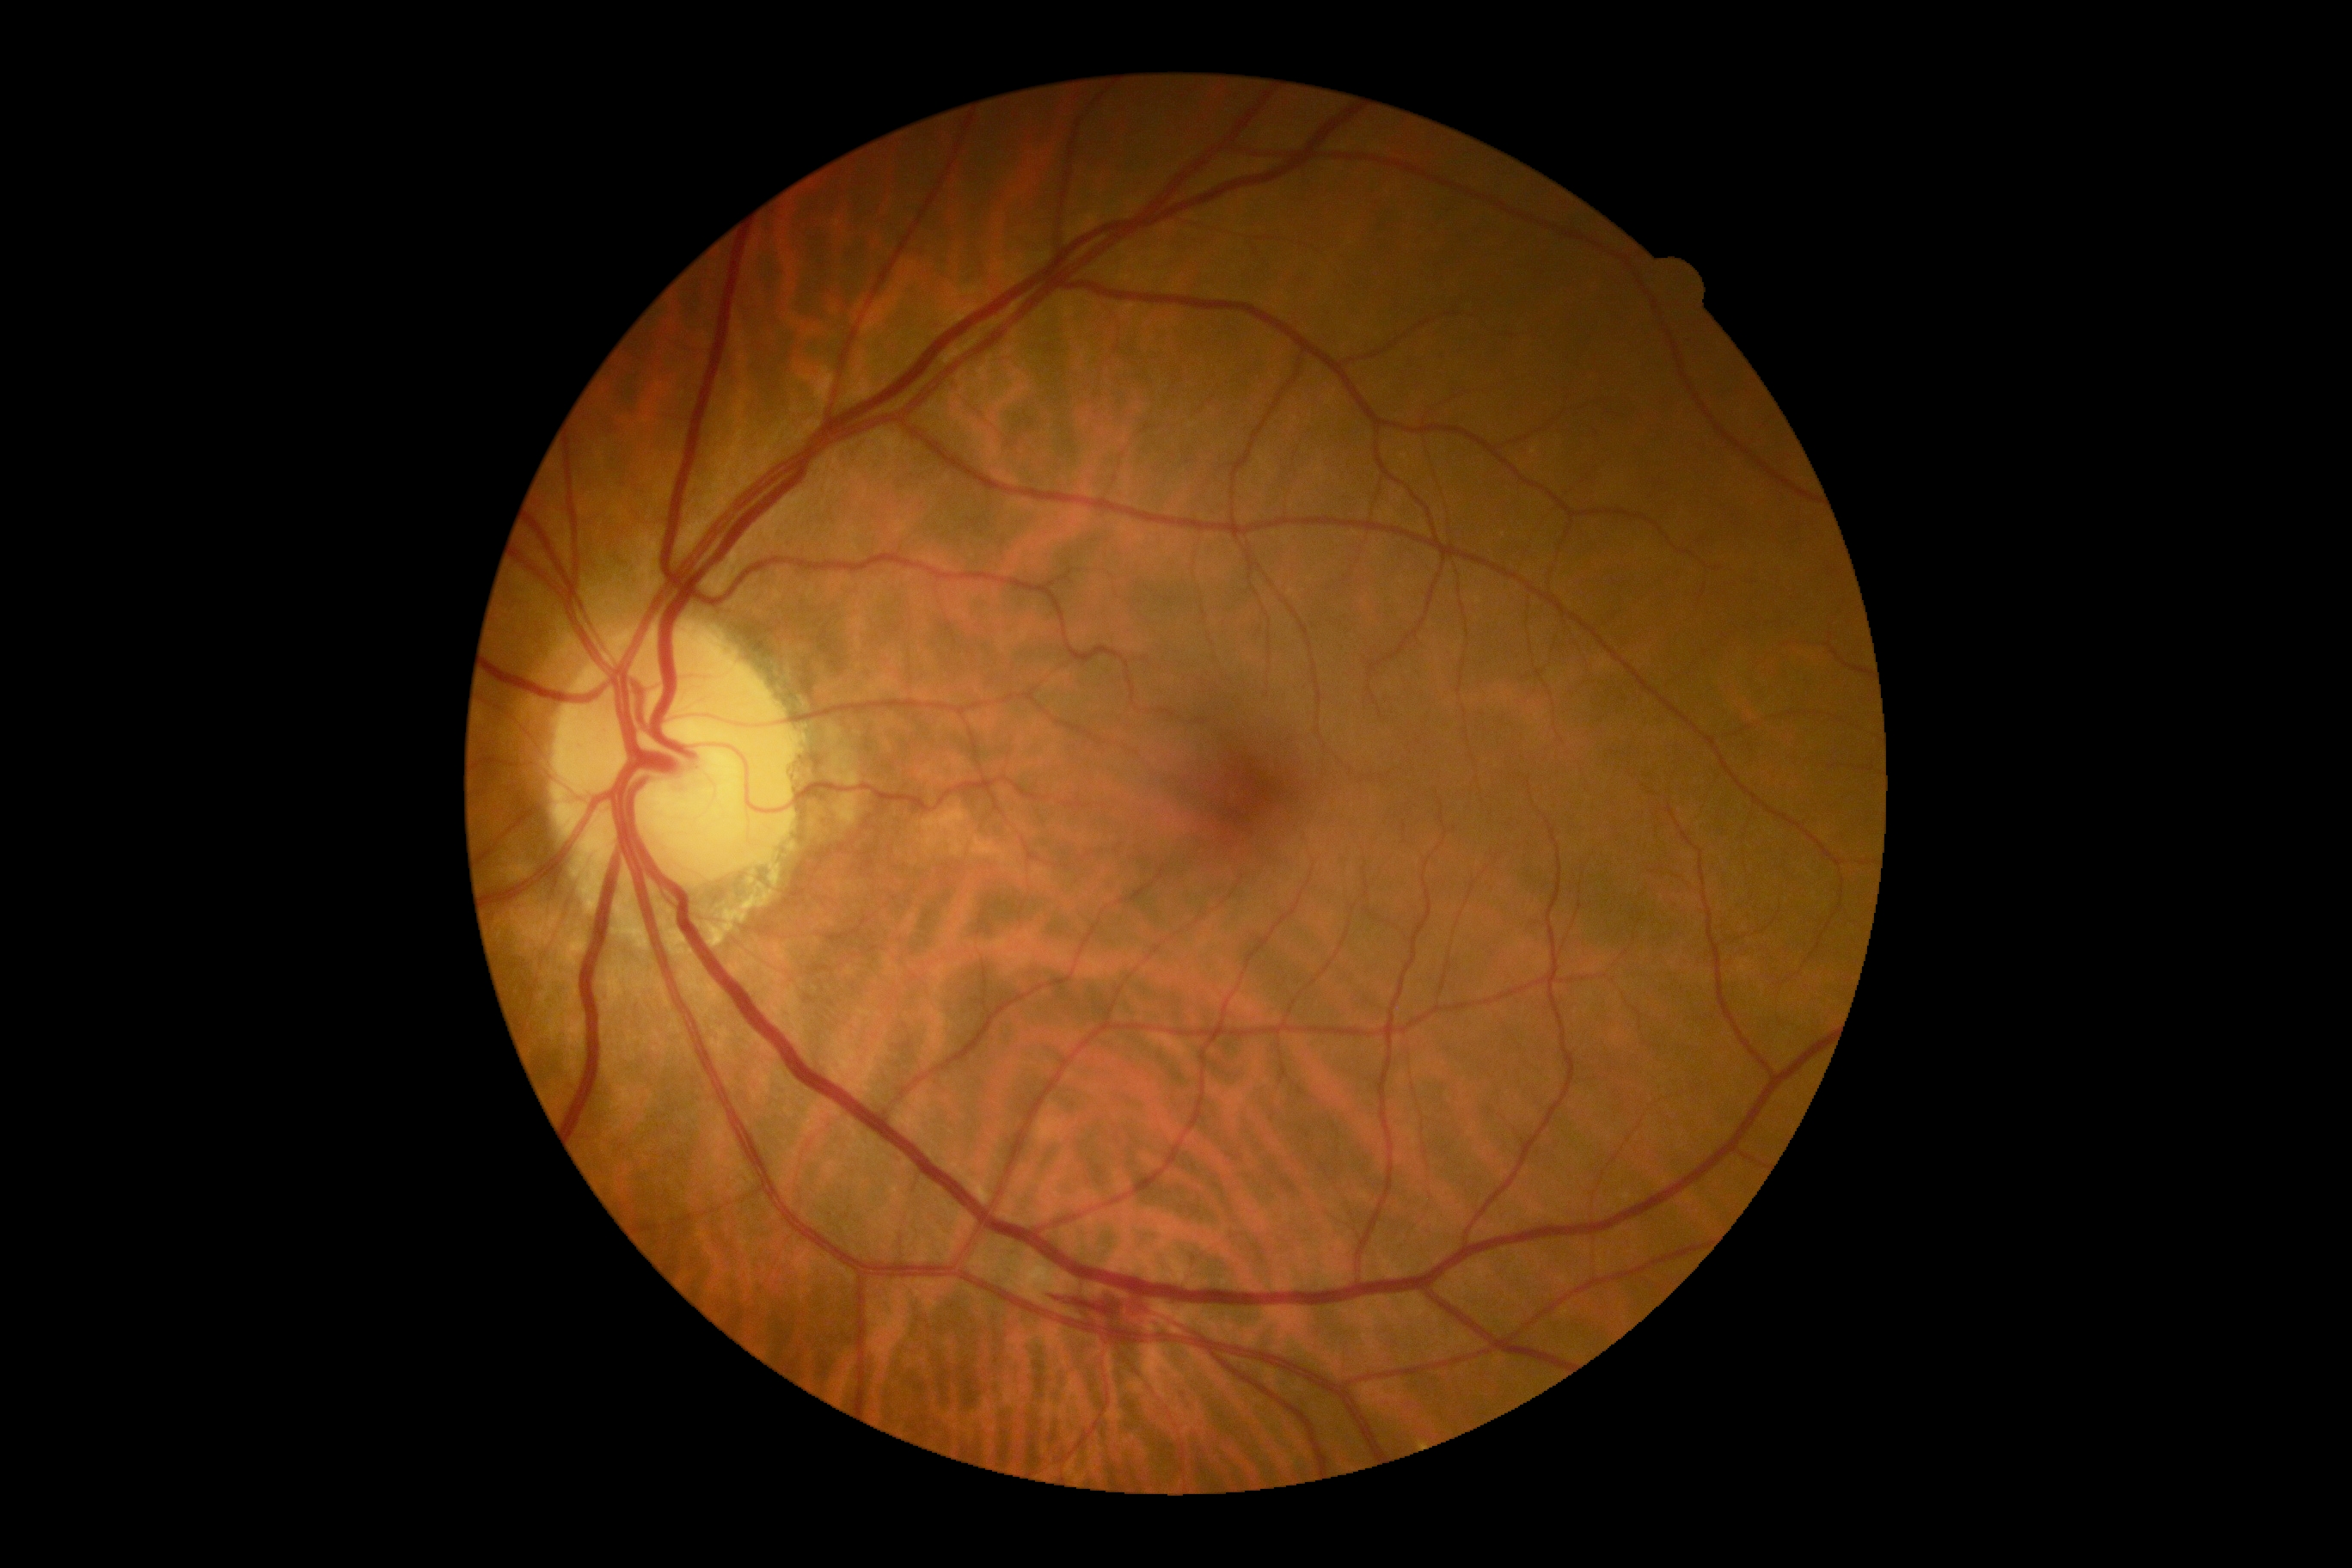

DR stage: grade 2 (moderate NPDR).